Modified Davis grading: 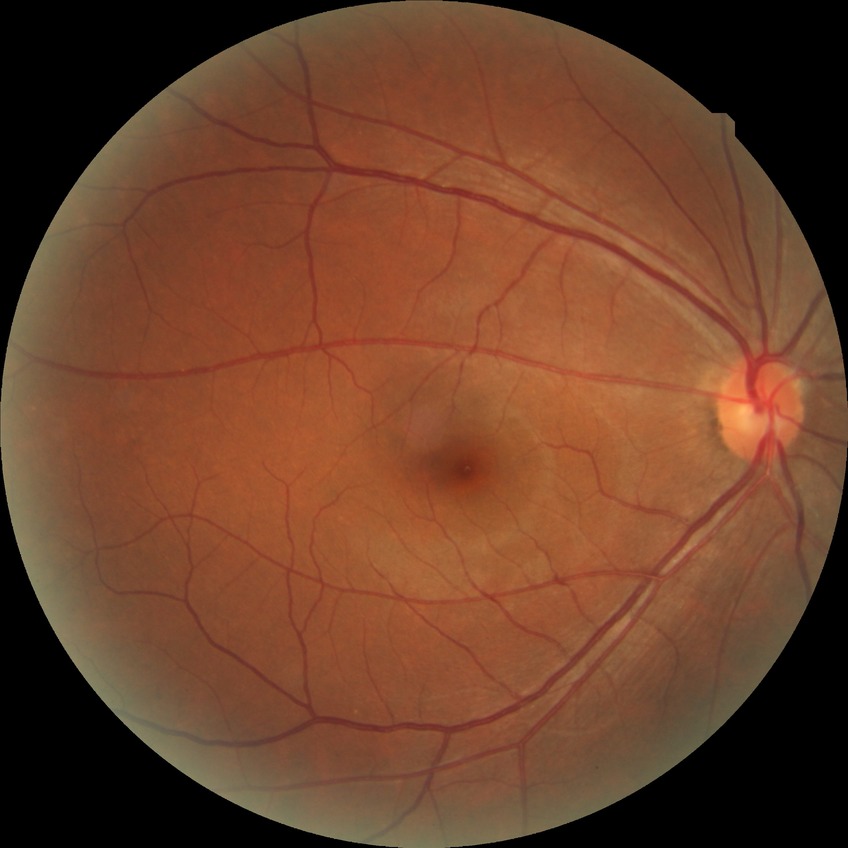

{
  "davis_grade": "no diabetic retinopathy"
}